CFP:
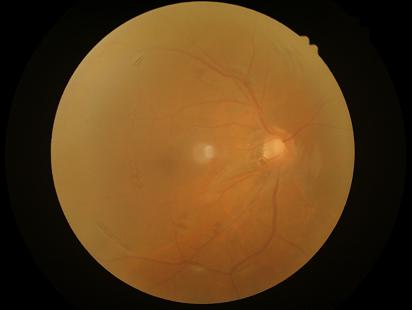 Contrast = low
Overall quality = low
Focus = reduced